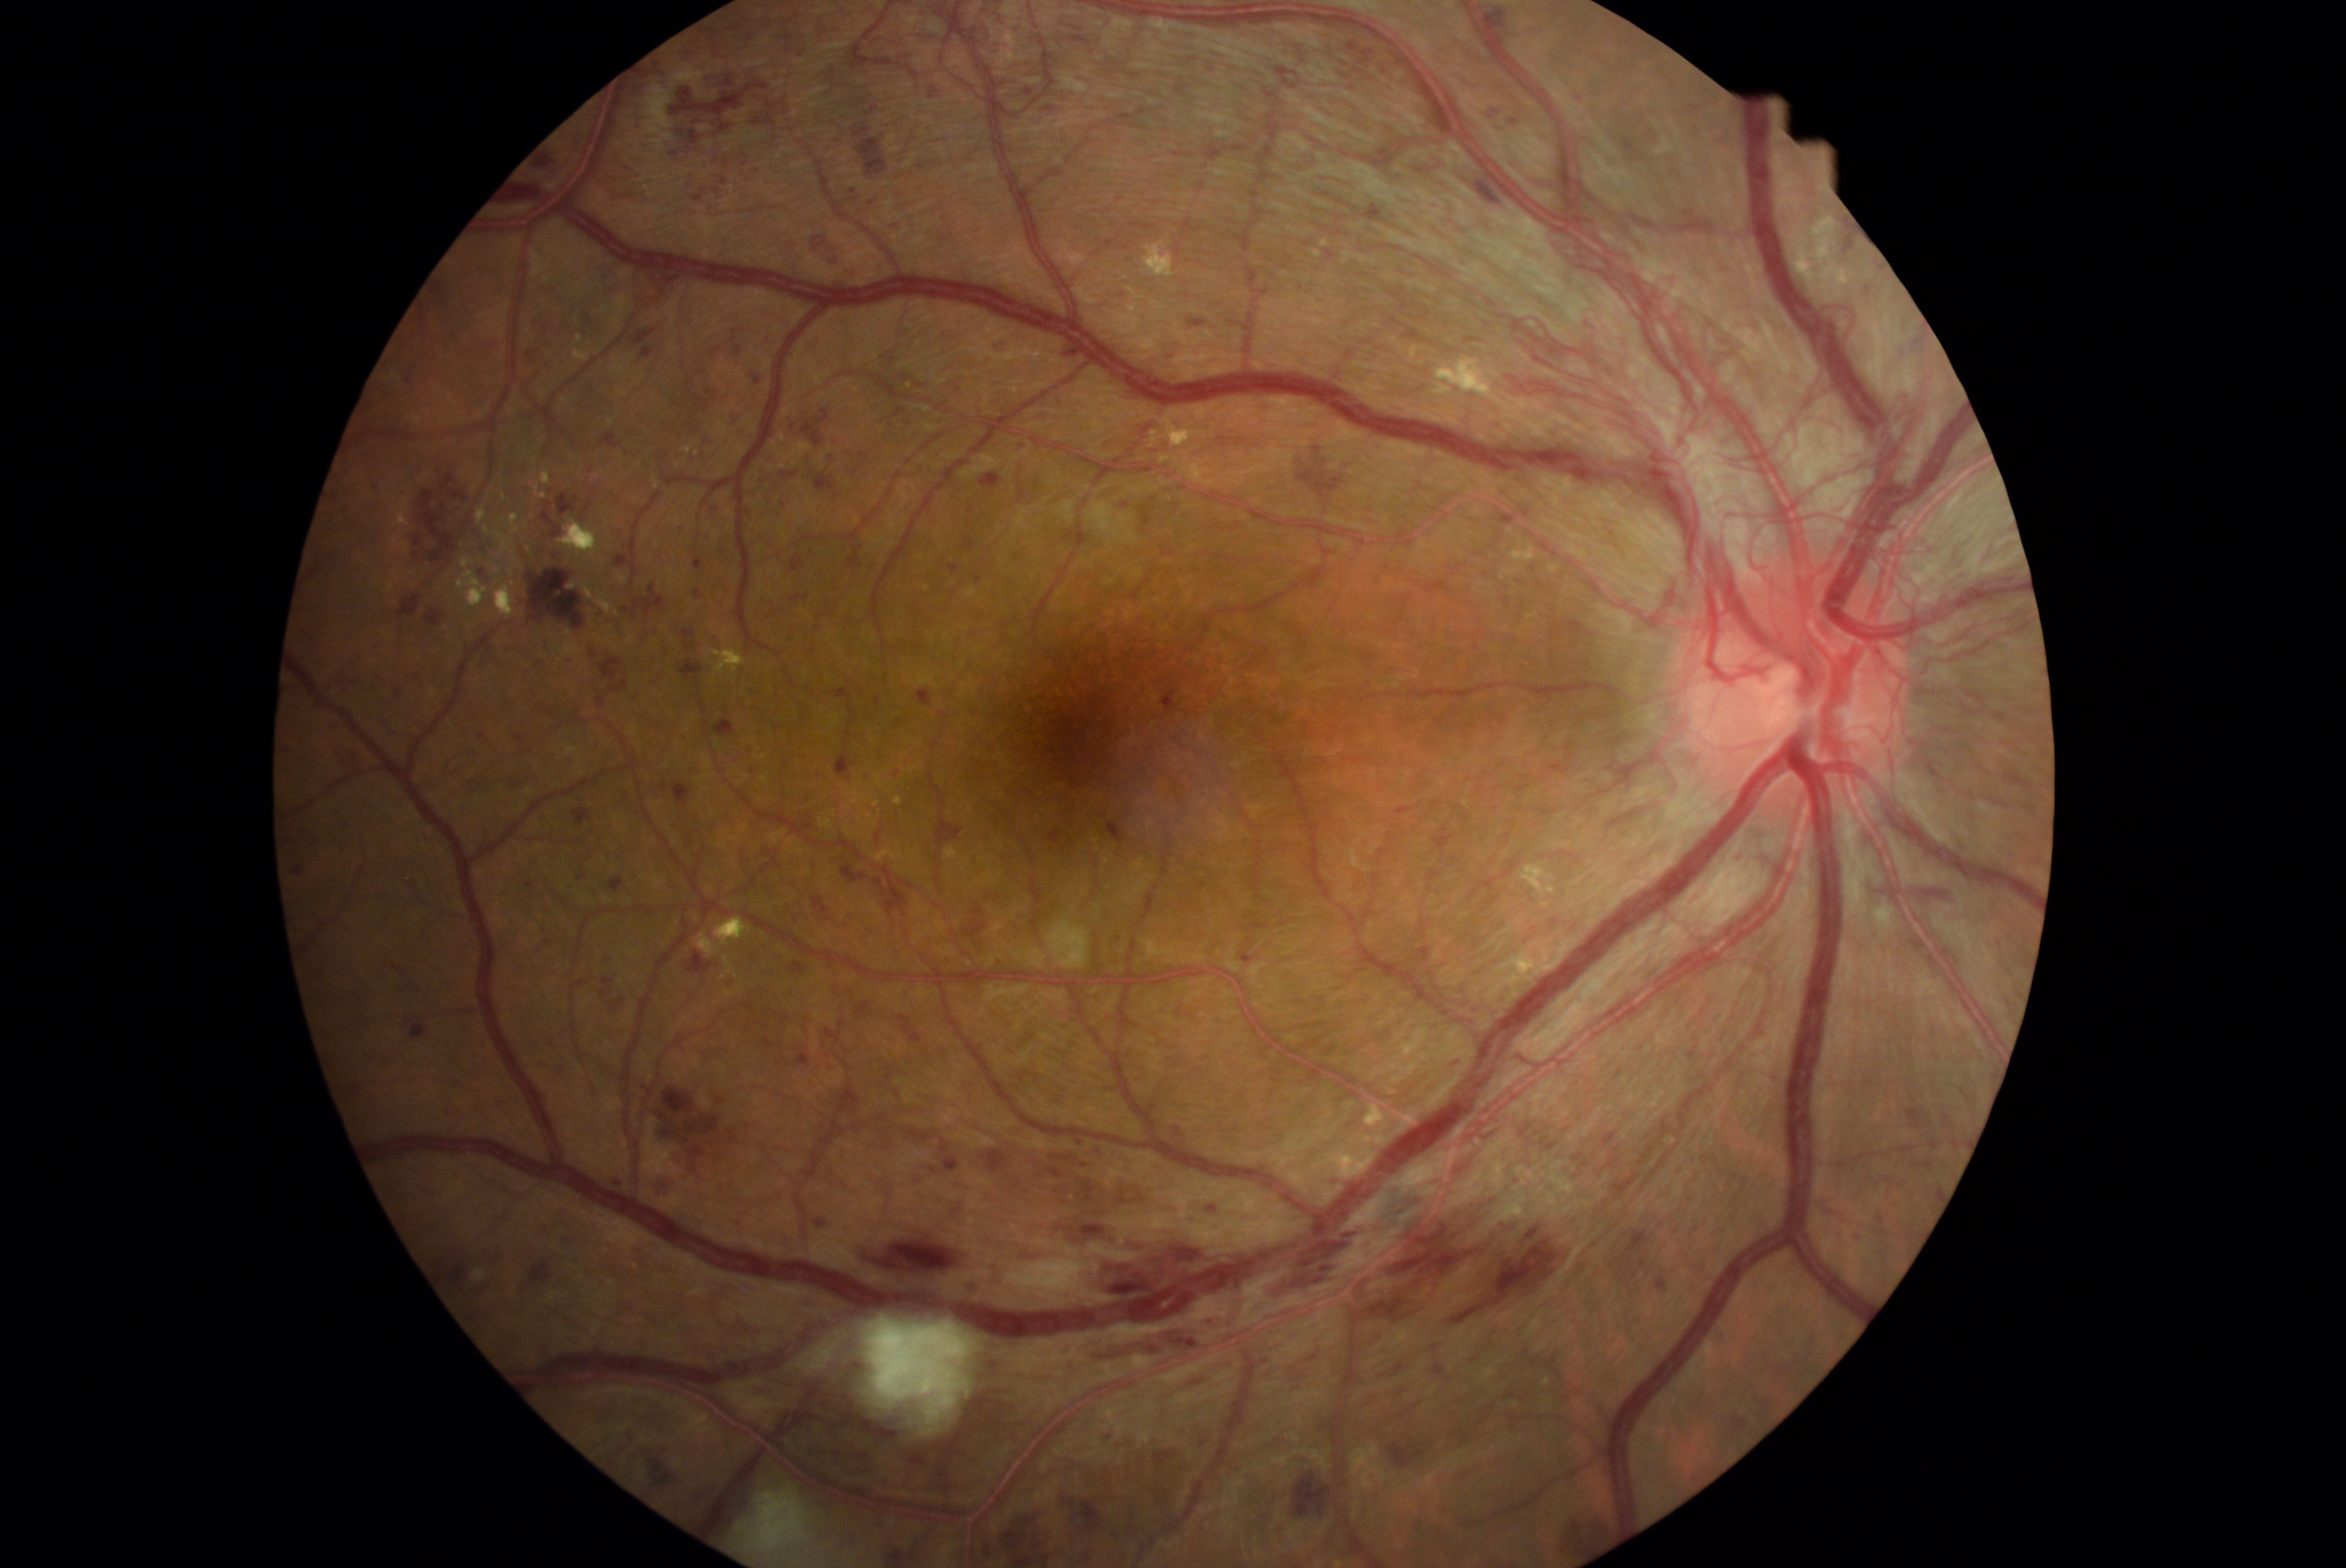
Diabetic retinopathy (DR) is grade 4
Lesions identified (partial list):
hemorrhages (HEs) (subset): [1683, 98, 1705, 114], [1445, 1059, 1461, 1072], [601, 256, 625, 274], [554, 1064, 565, 1078], [1208, 1207, 1218, 1211], [554, 528, 561, 537], [1605, 802, 1666, 827], [1200, 1431, 1215, 1450], [901, 1015, 923, 1045], [526, 318, 573, 377], [670, 68, 786, 147], [1230, 319, 1246, 327], [542, 499, 554, 523], [1429, 1345, 1456, 1382], [738, 154, 749, 164], [1690, 1048, 1698, 1059], [592, 1406, 617, 1426], [493, 1095, 509, 1109]
Small HEs near <point>876, 448</point>, <point>1623, 1280</point>